45° field of view, CFP:
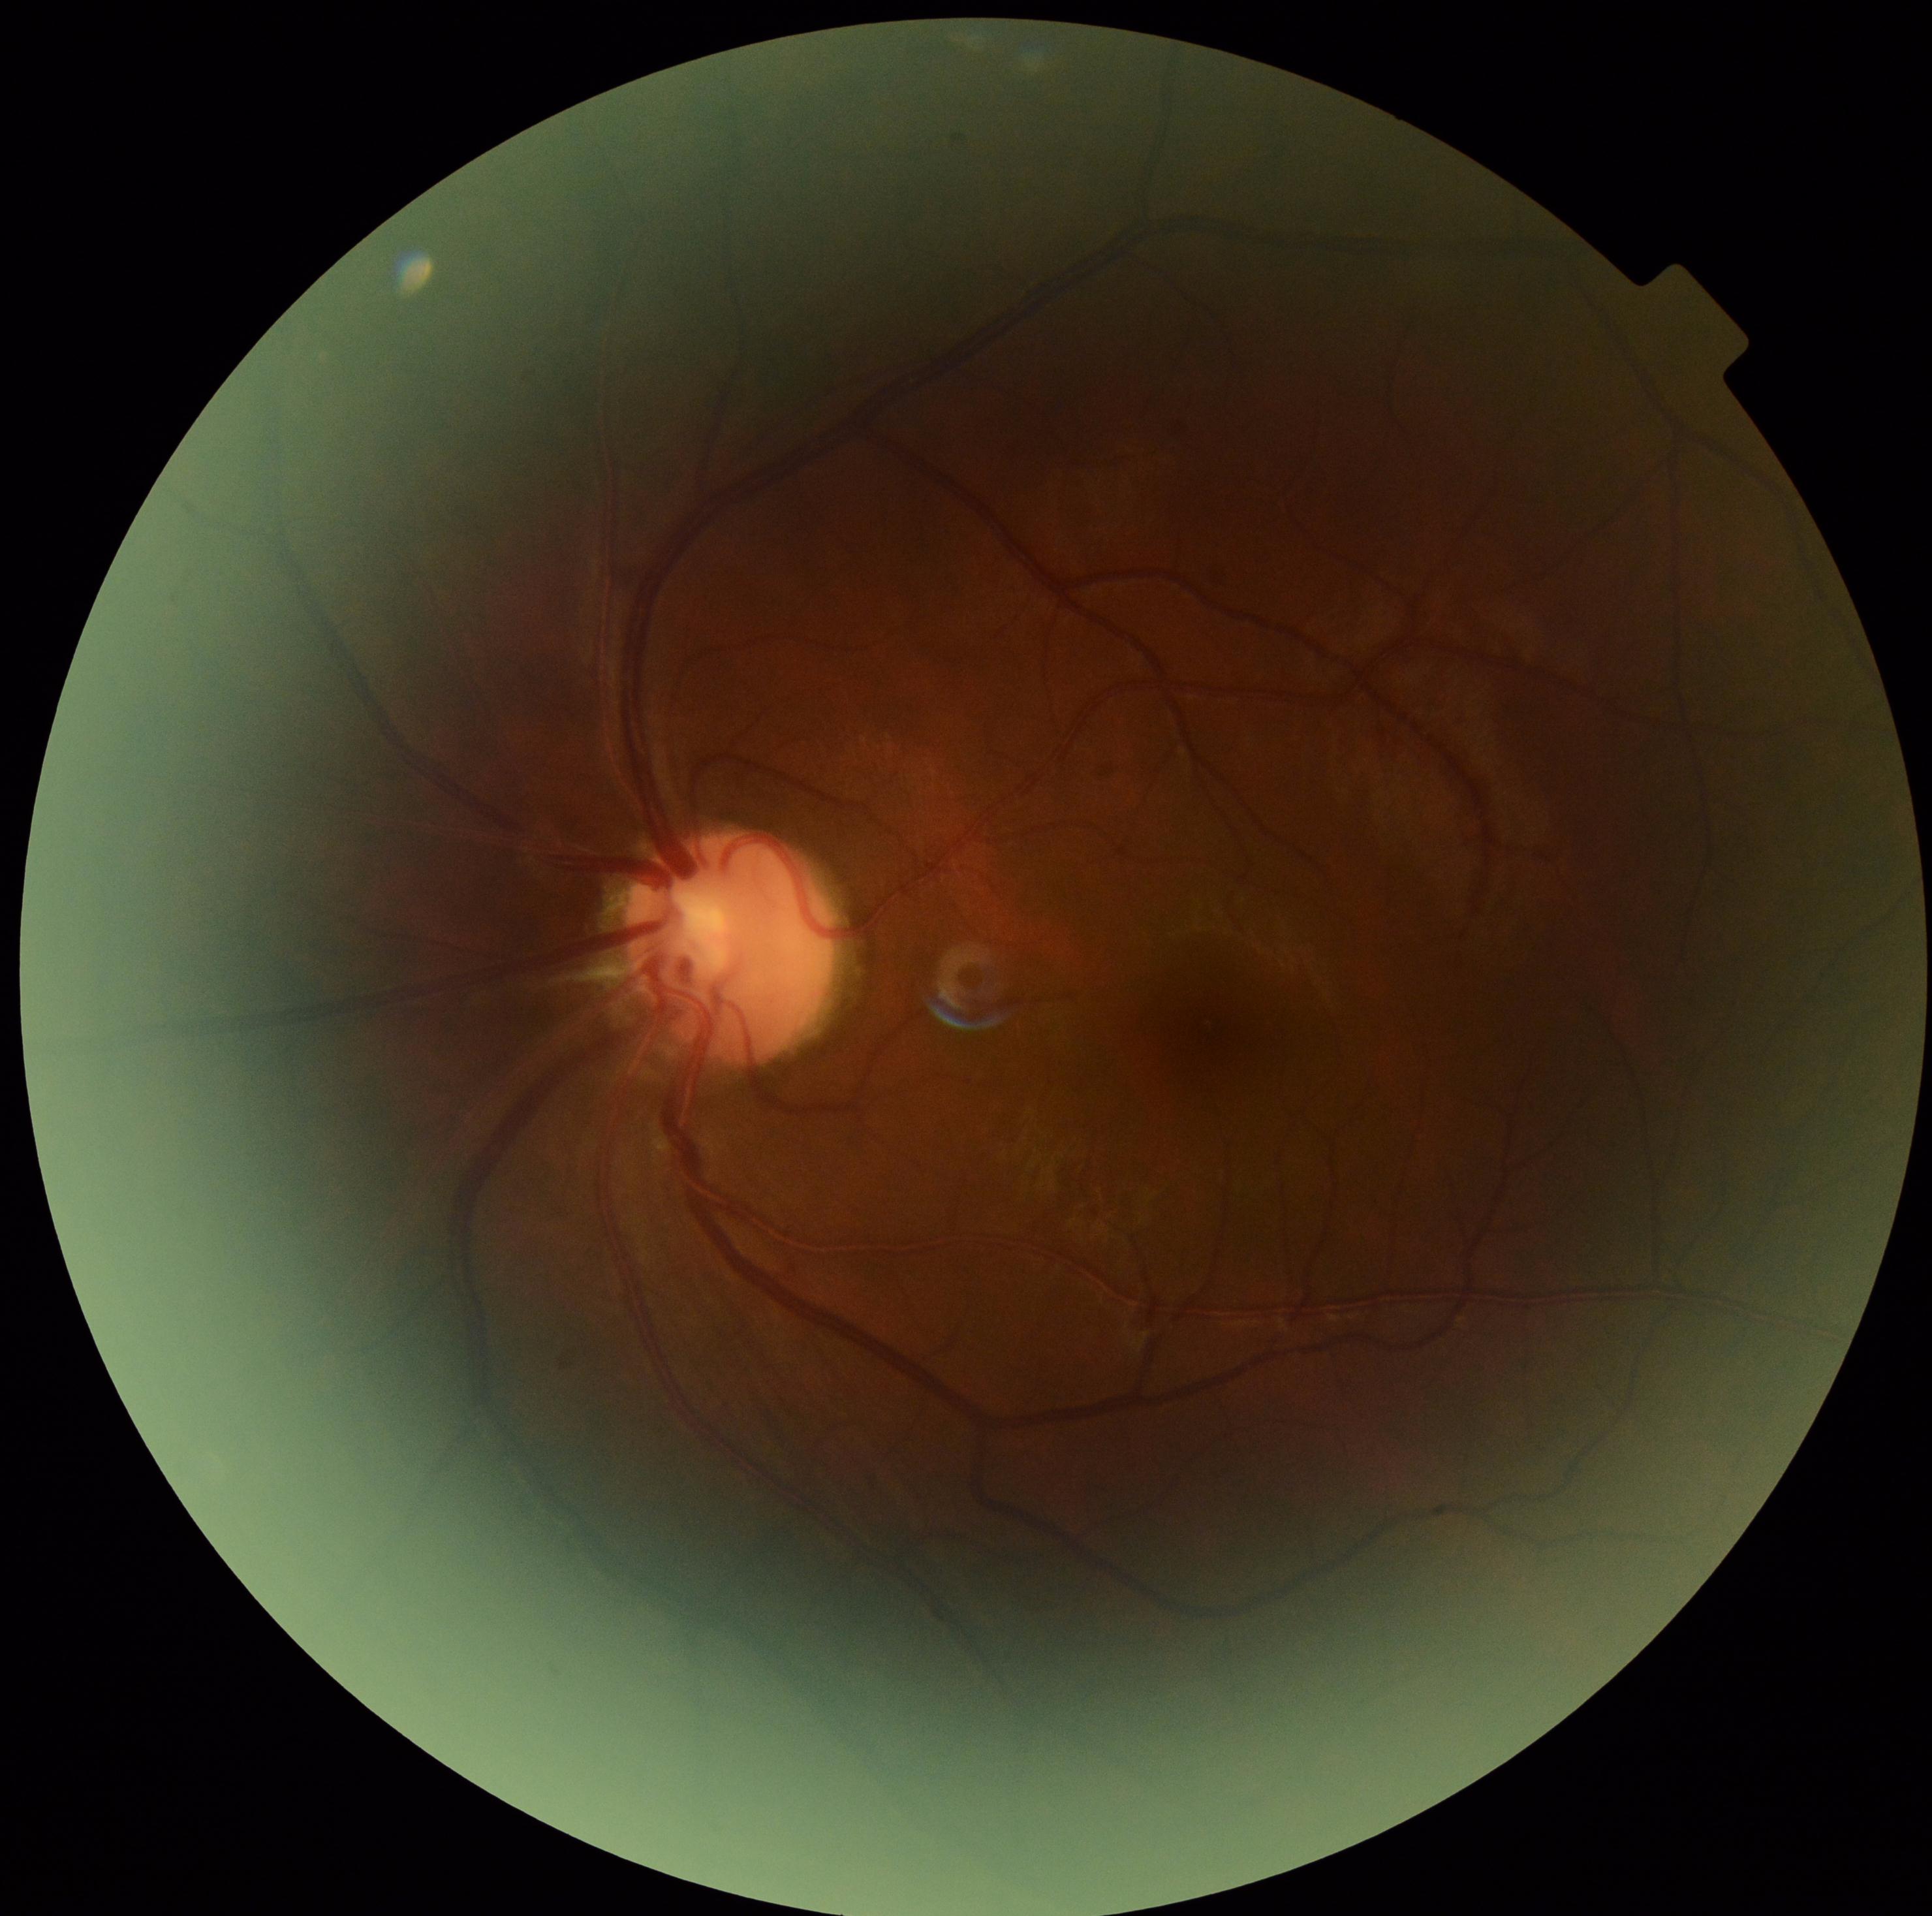

DR severity: grade 1 (mild NPDR)